Wide-field fundus photograph of an infant. Camera: Phoenix ICON (100° FOV). 1240 by 1240 pixels:
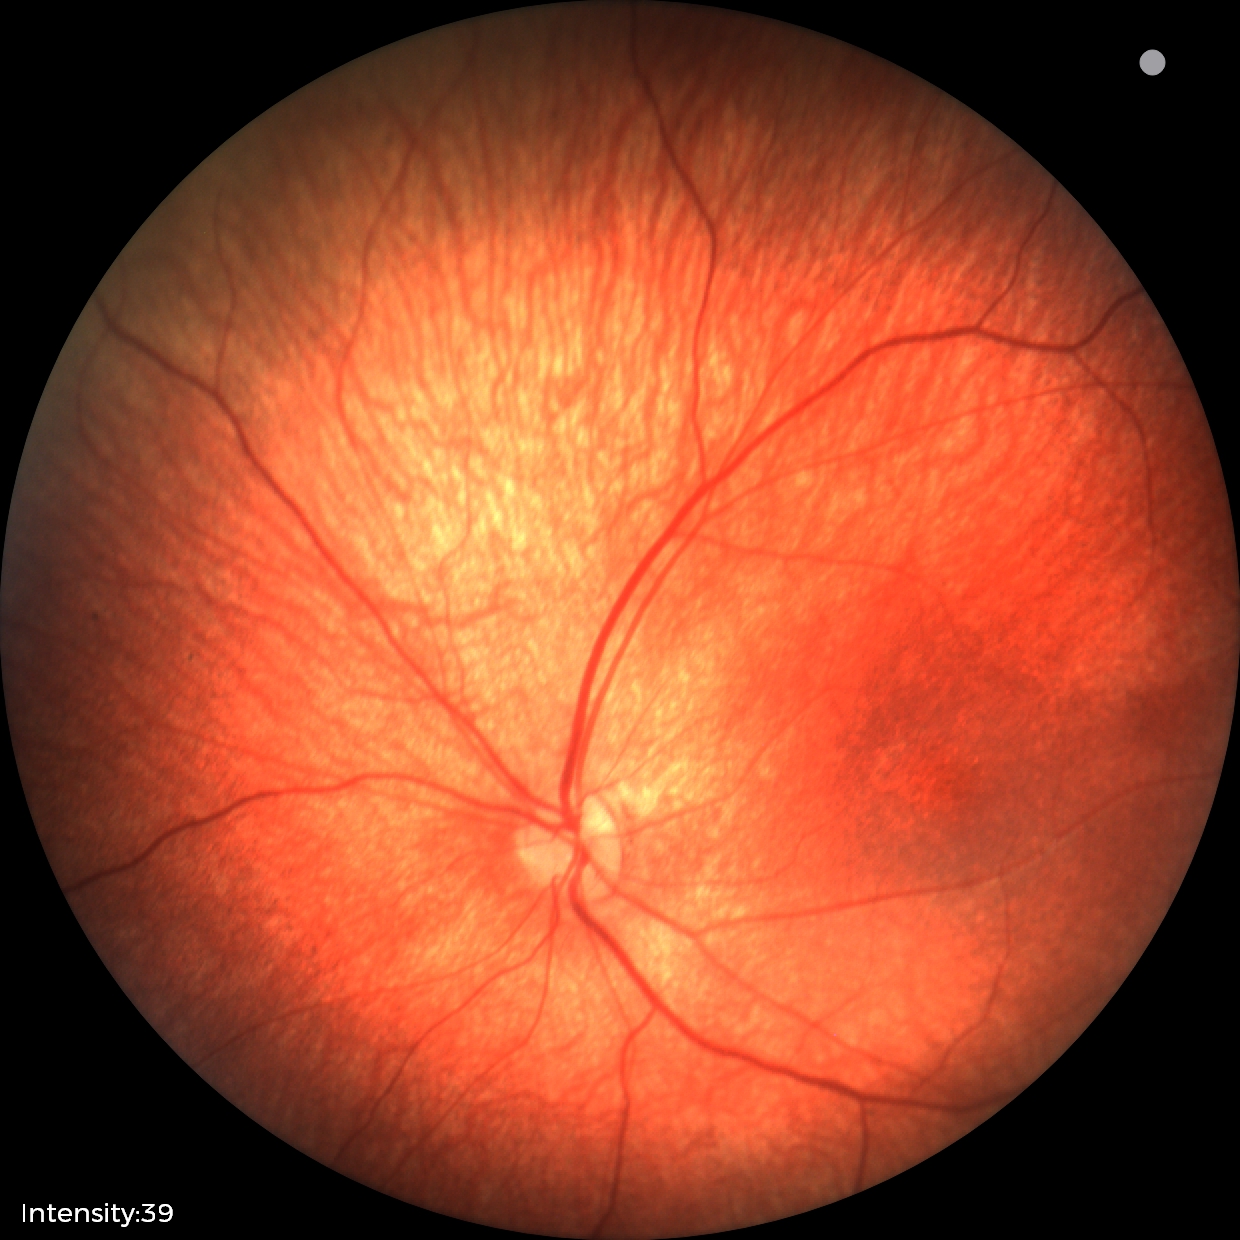 Diagnosis from this screening exam: retinal hemorrhages.